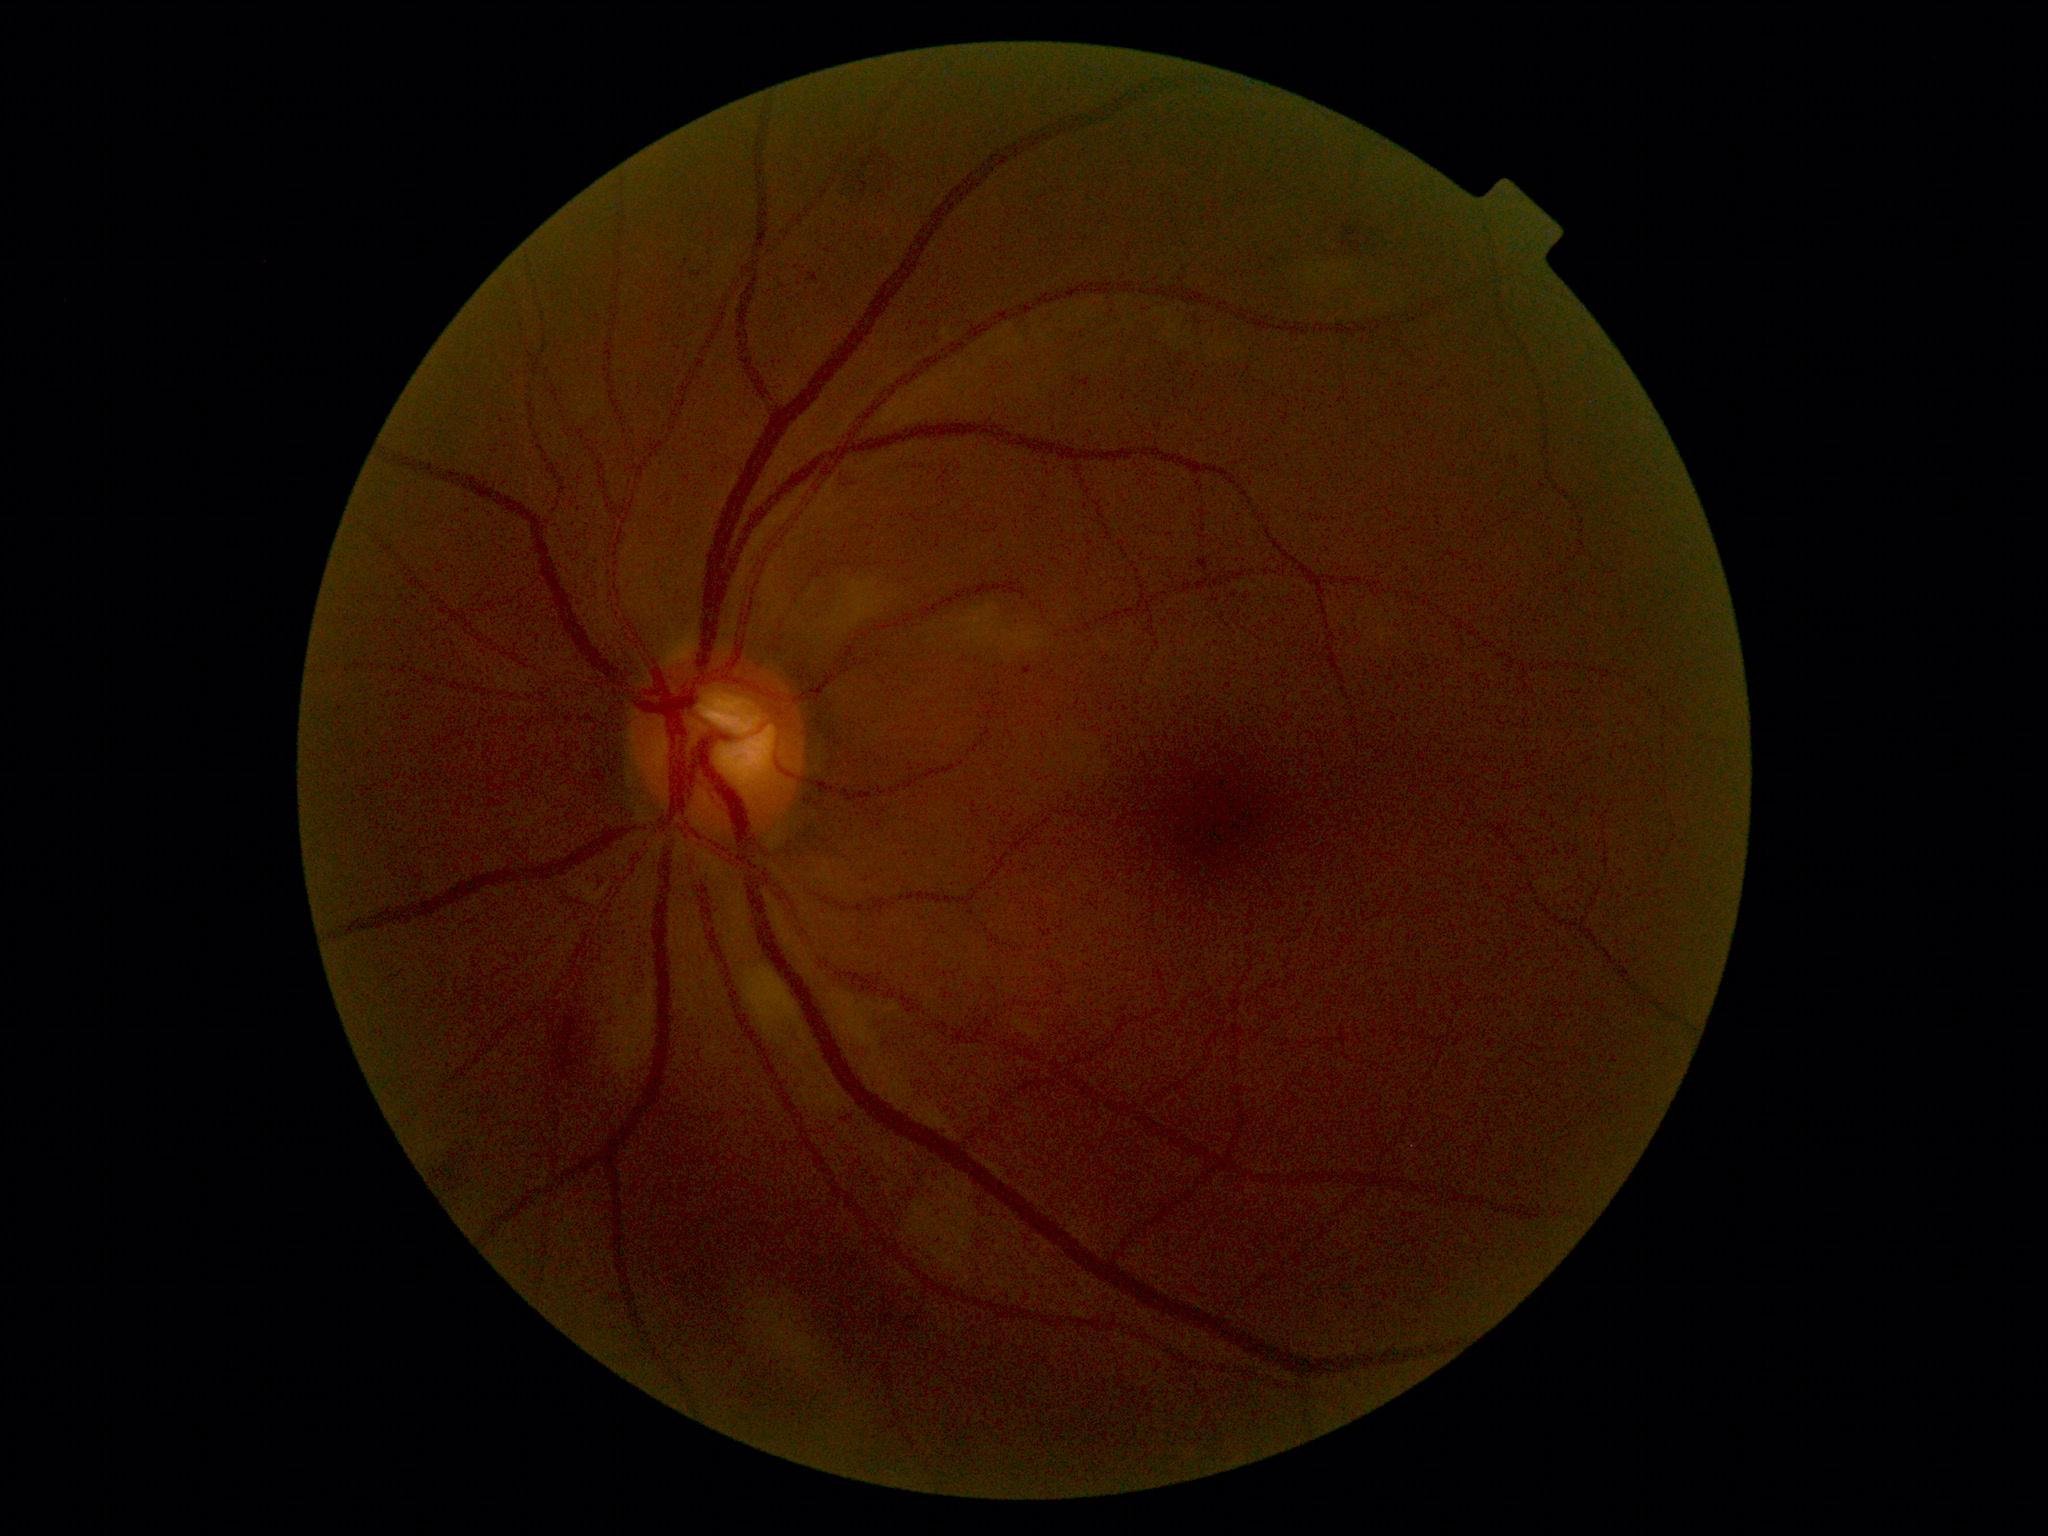
DR stage is grade 2.